Wide-field fundus photograph of an infant. Captured with the Natus RetCam Envision (130° field of view): 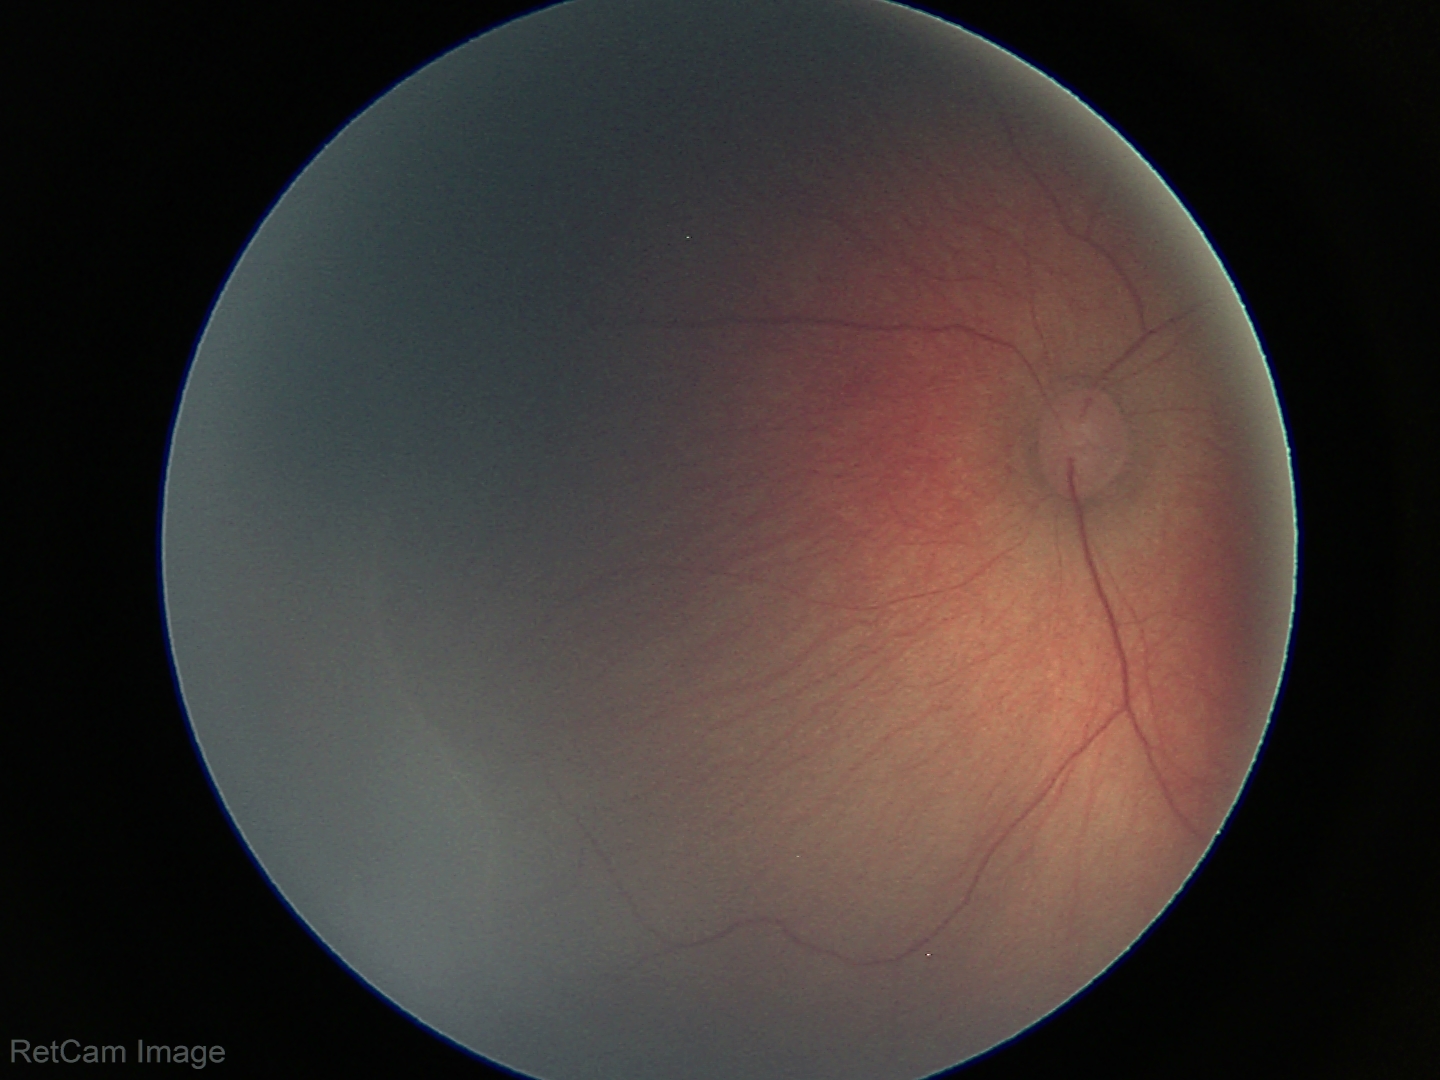

Plus disease = absent | screening diagnosis = retinopathy of prematurity (ROP) stage 1 — demarcation line between vascular and avascular retina.